Optic disc-centered crop:
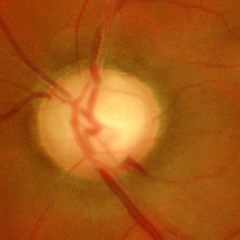

Optic nerve head appearance consistent with advanced glaucomatous optic neuropathy.